Mydriatic (tropicamide and phenylephrine):
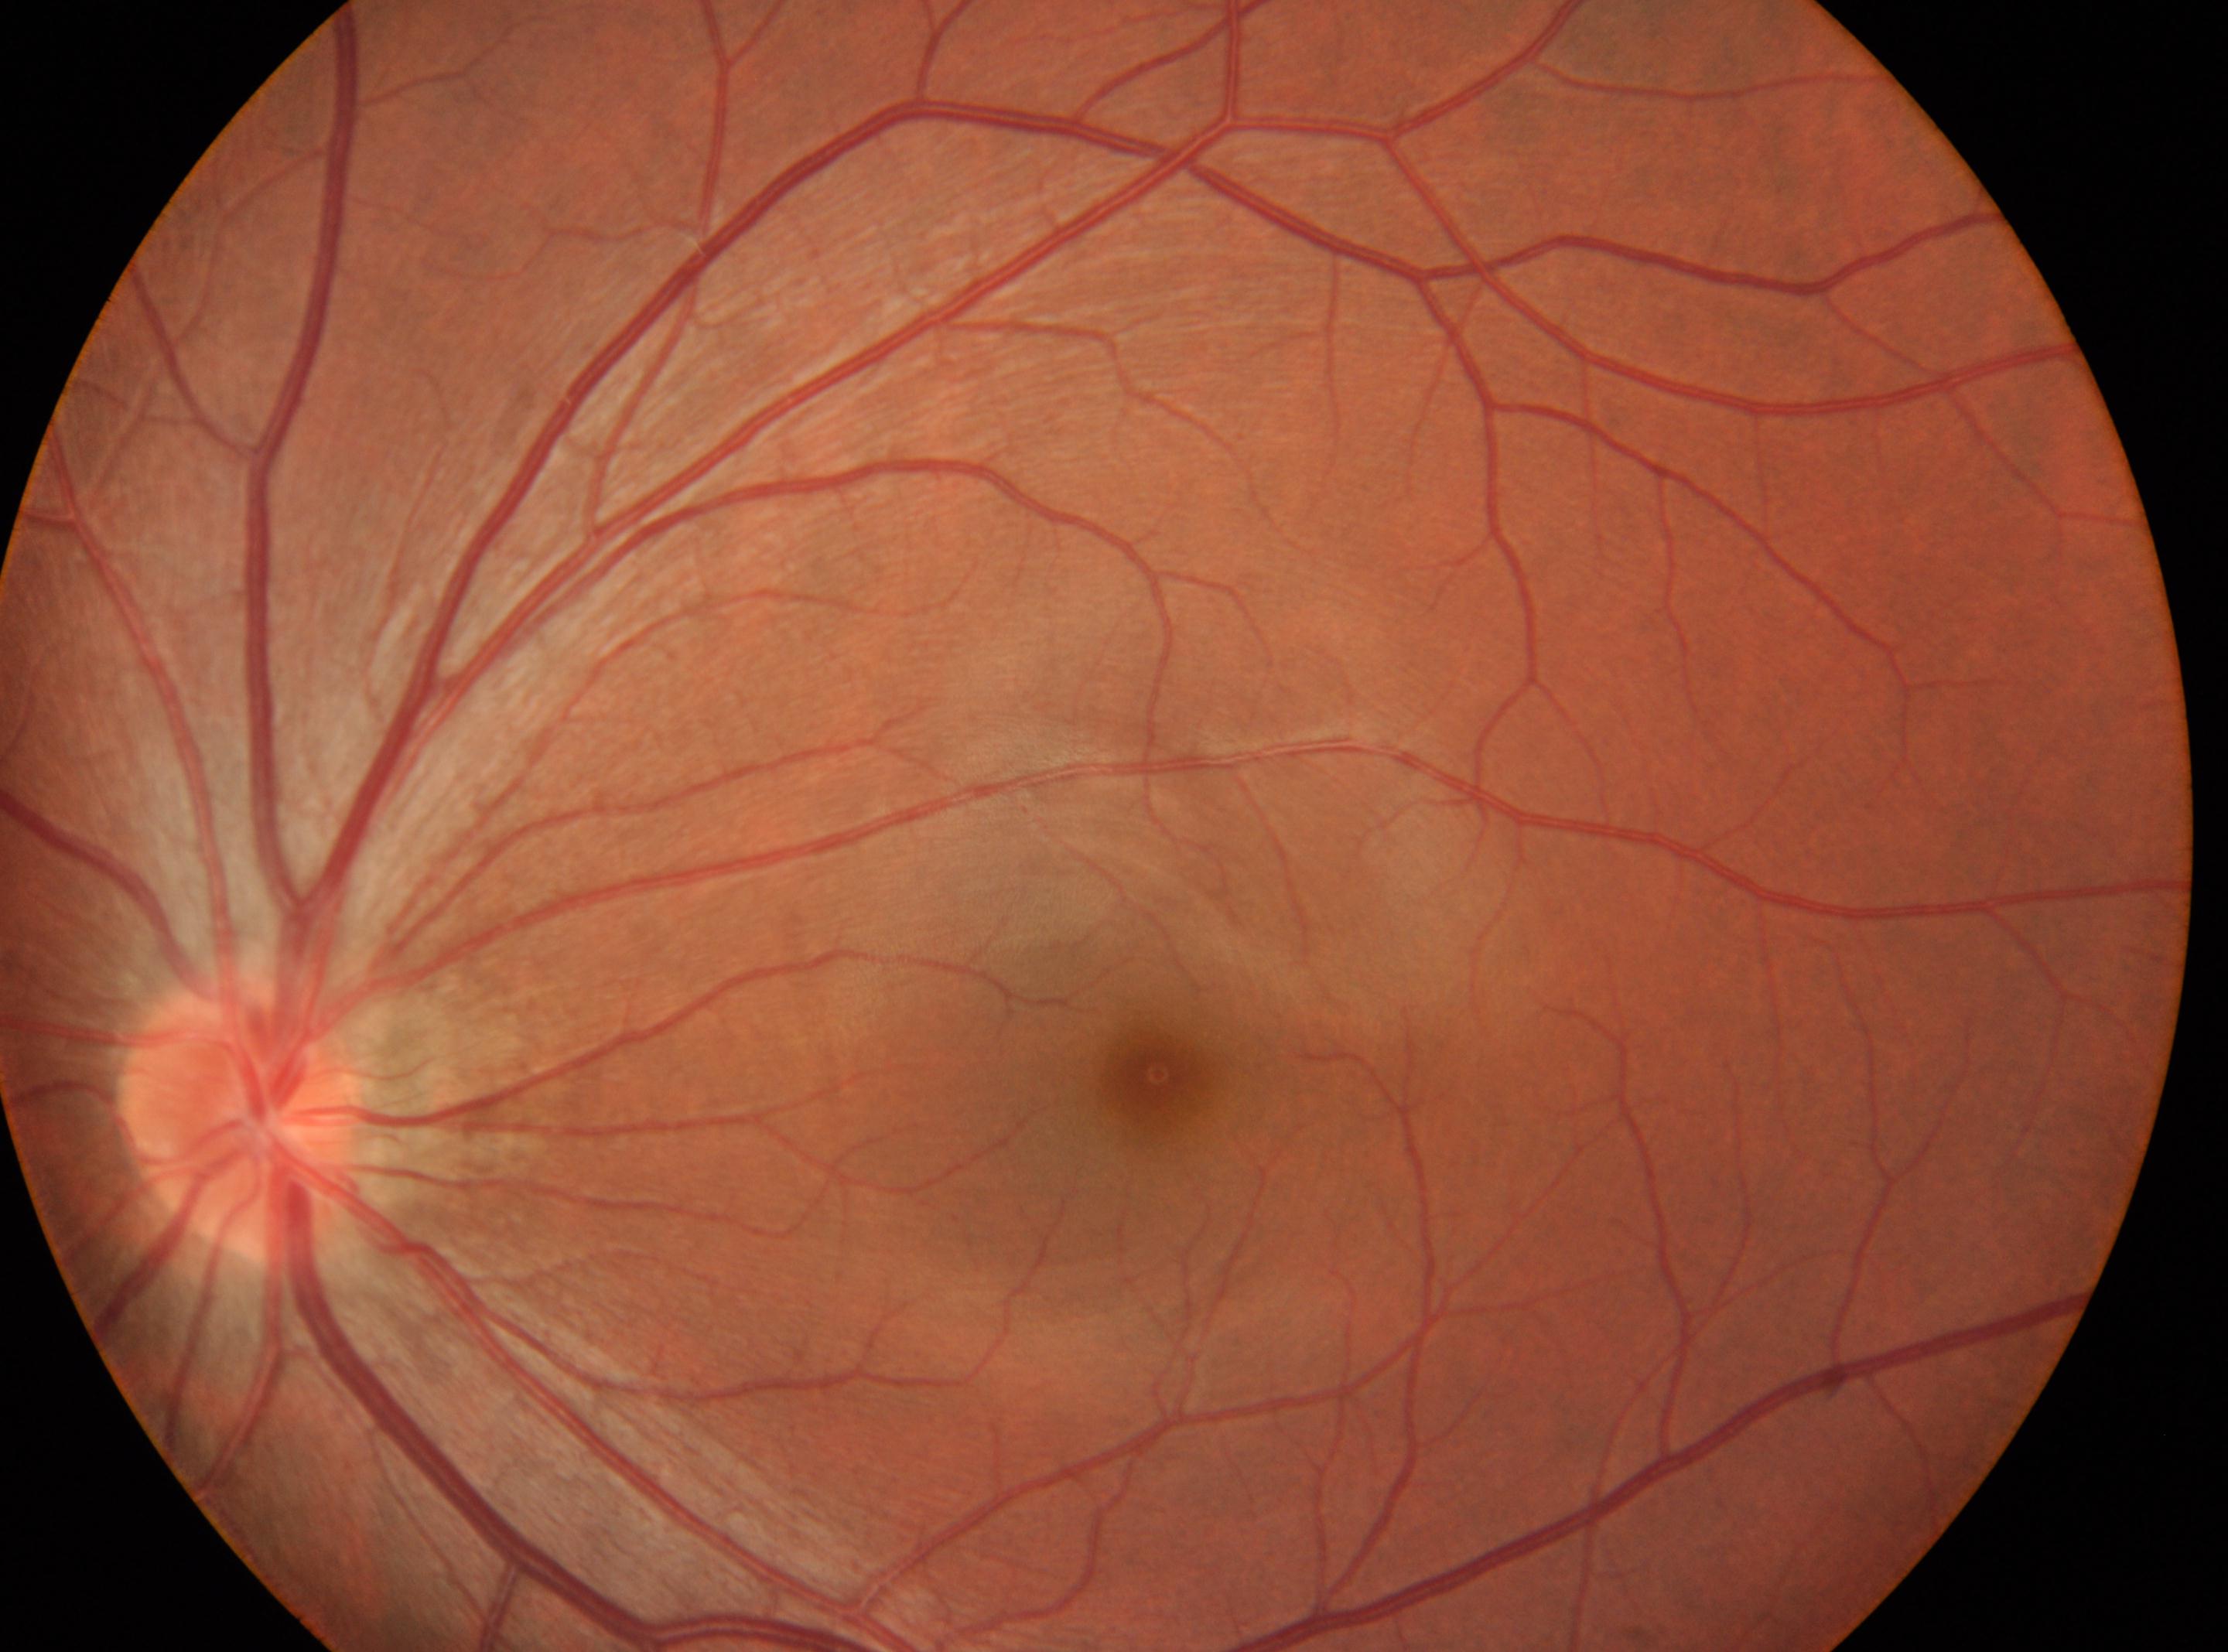

Diabetic retinopathy severity: no apparent retinopathy (grade 0). Eye: the left eye. The fovea centralis is at [1157, 1073]. Disc center: [238, 1116].